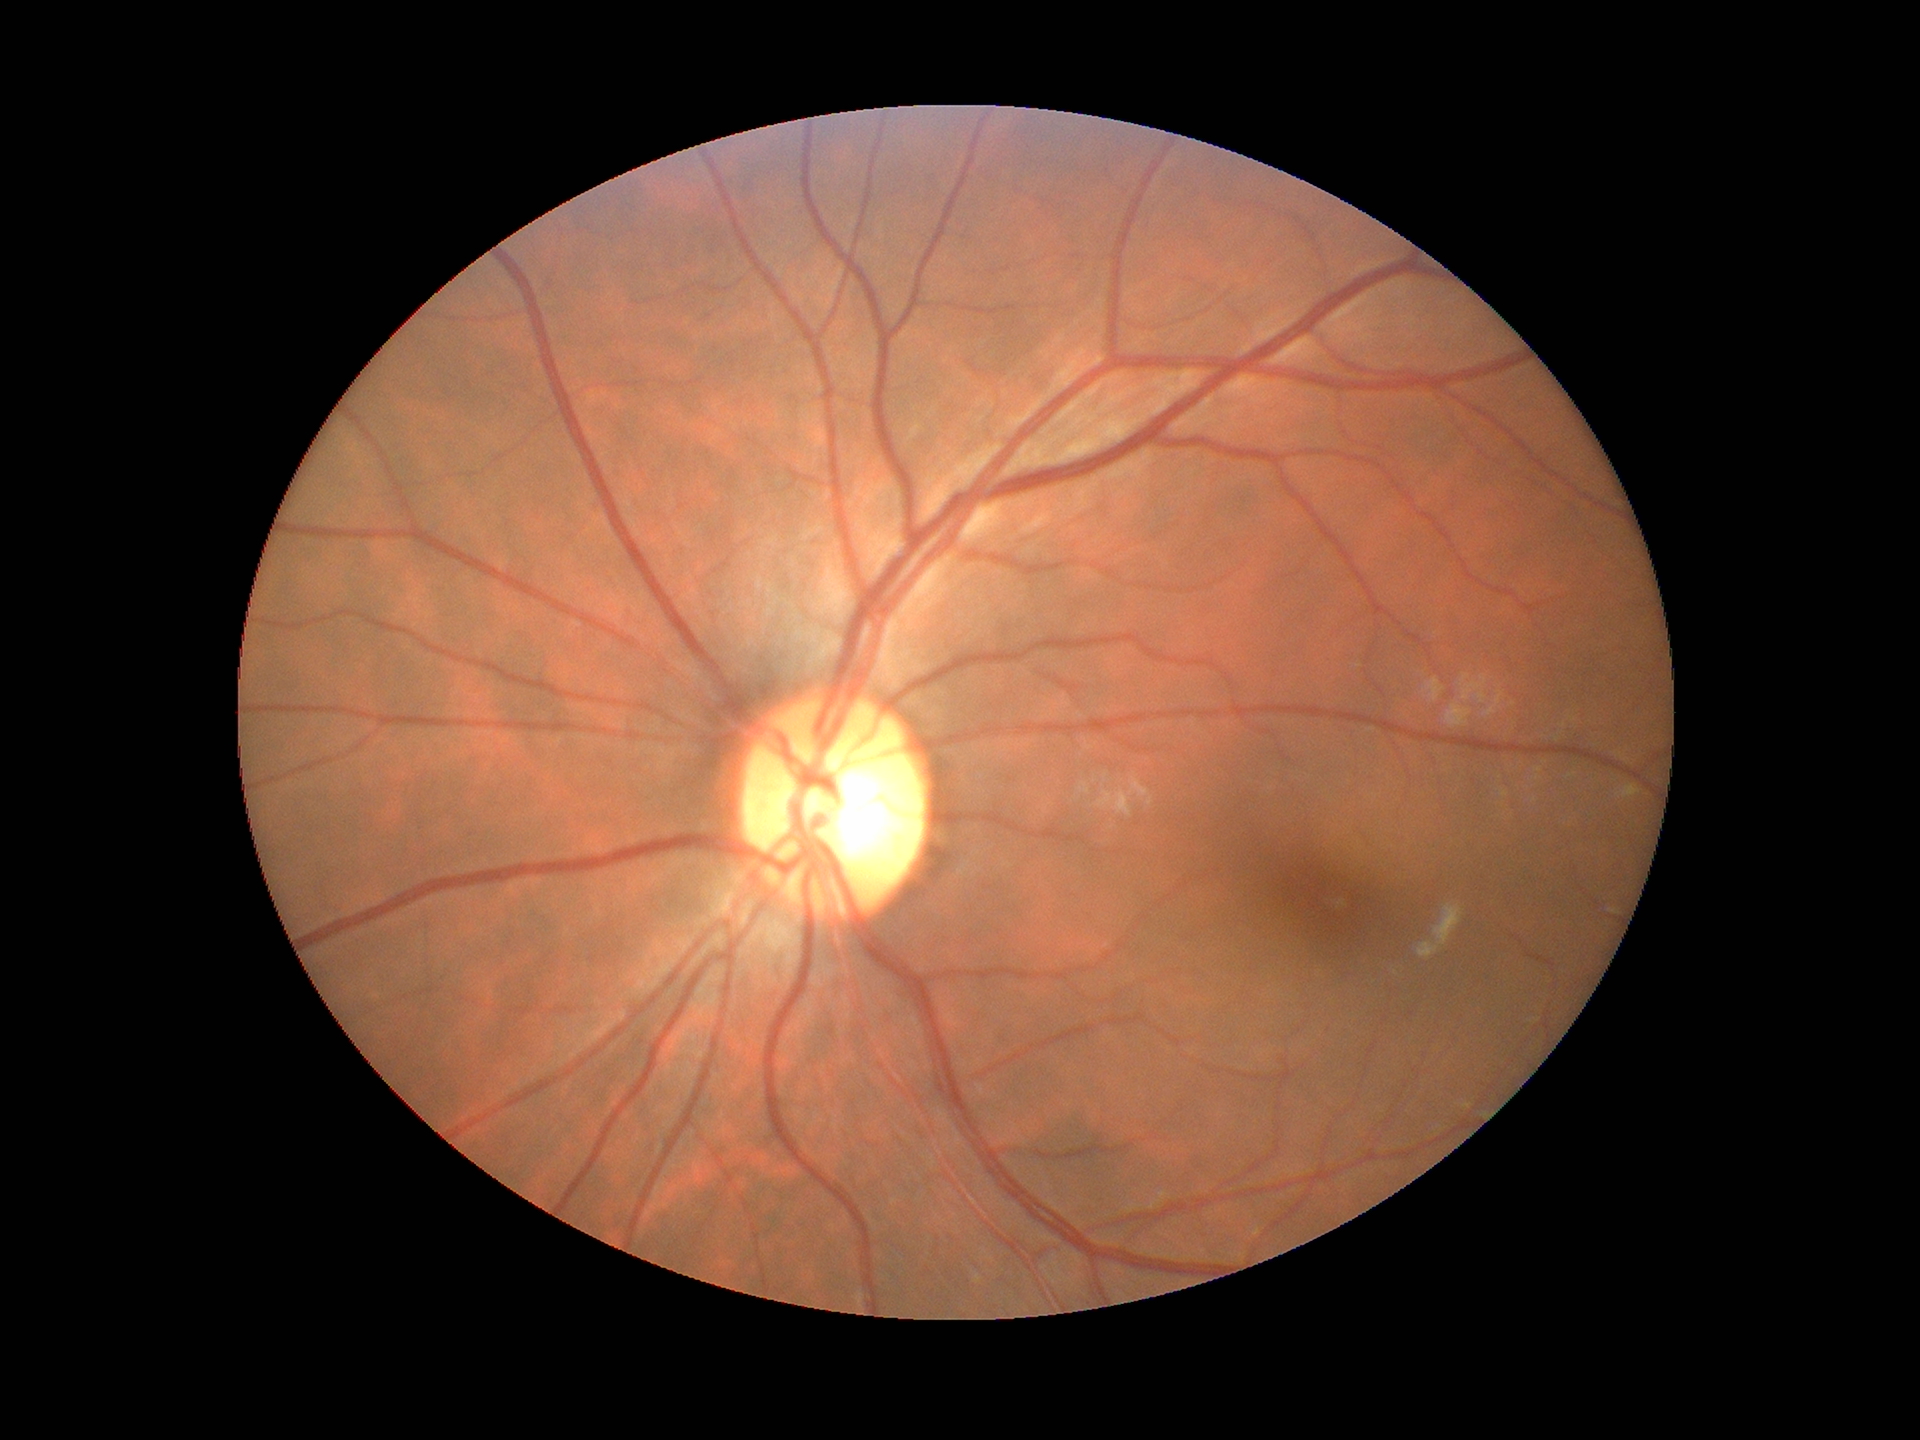 Annotations:
* Glaucoma screening · not suspect (one of five ophthalmologists flagged glaucoma suspect)
* vertical cup-to-disc ratio (VCDR) · 0.52